NIDEK AFC-230 fundus camera, 45° FOV, retinal fundus photograph, nonmydriatic fundus photograph, 848 x 848 pixels — 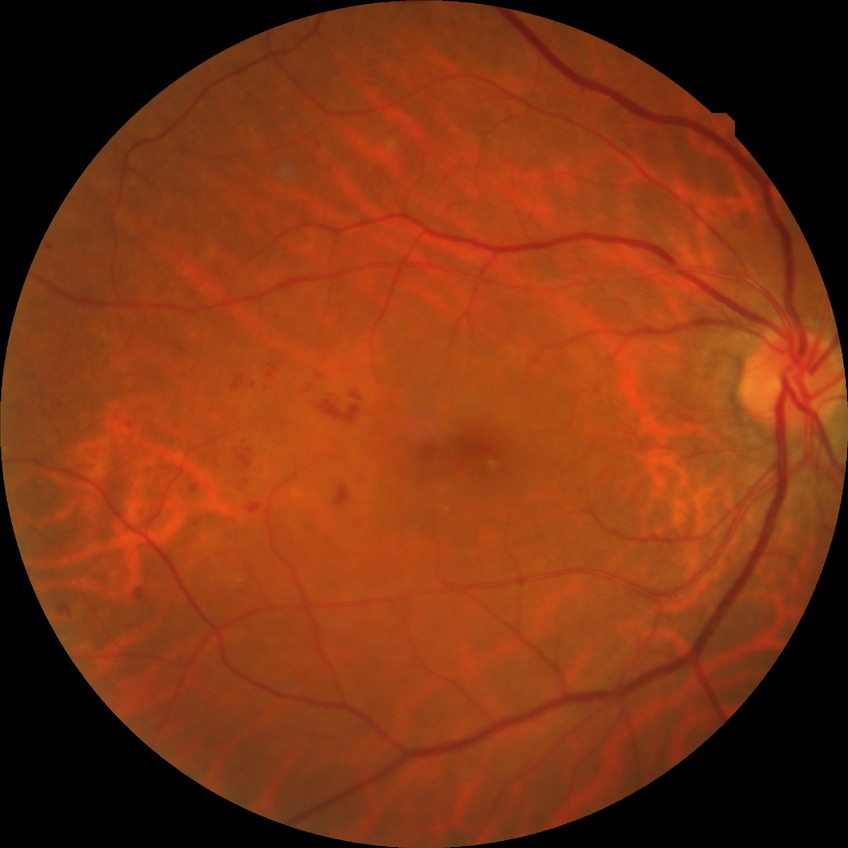
Disease class: non-proliferative diabetic retinopathy.
Modified Davis grading is simple diabetic retinopathy.